Color fundus image:
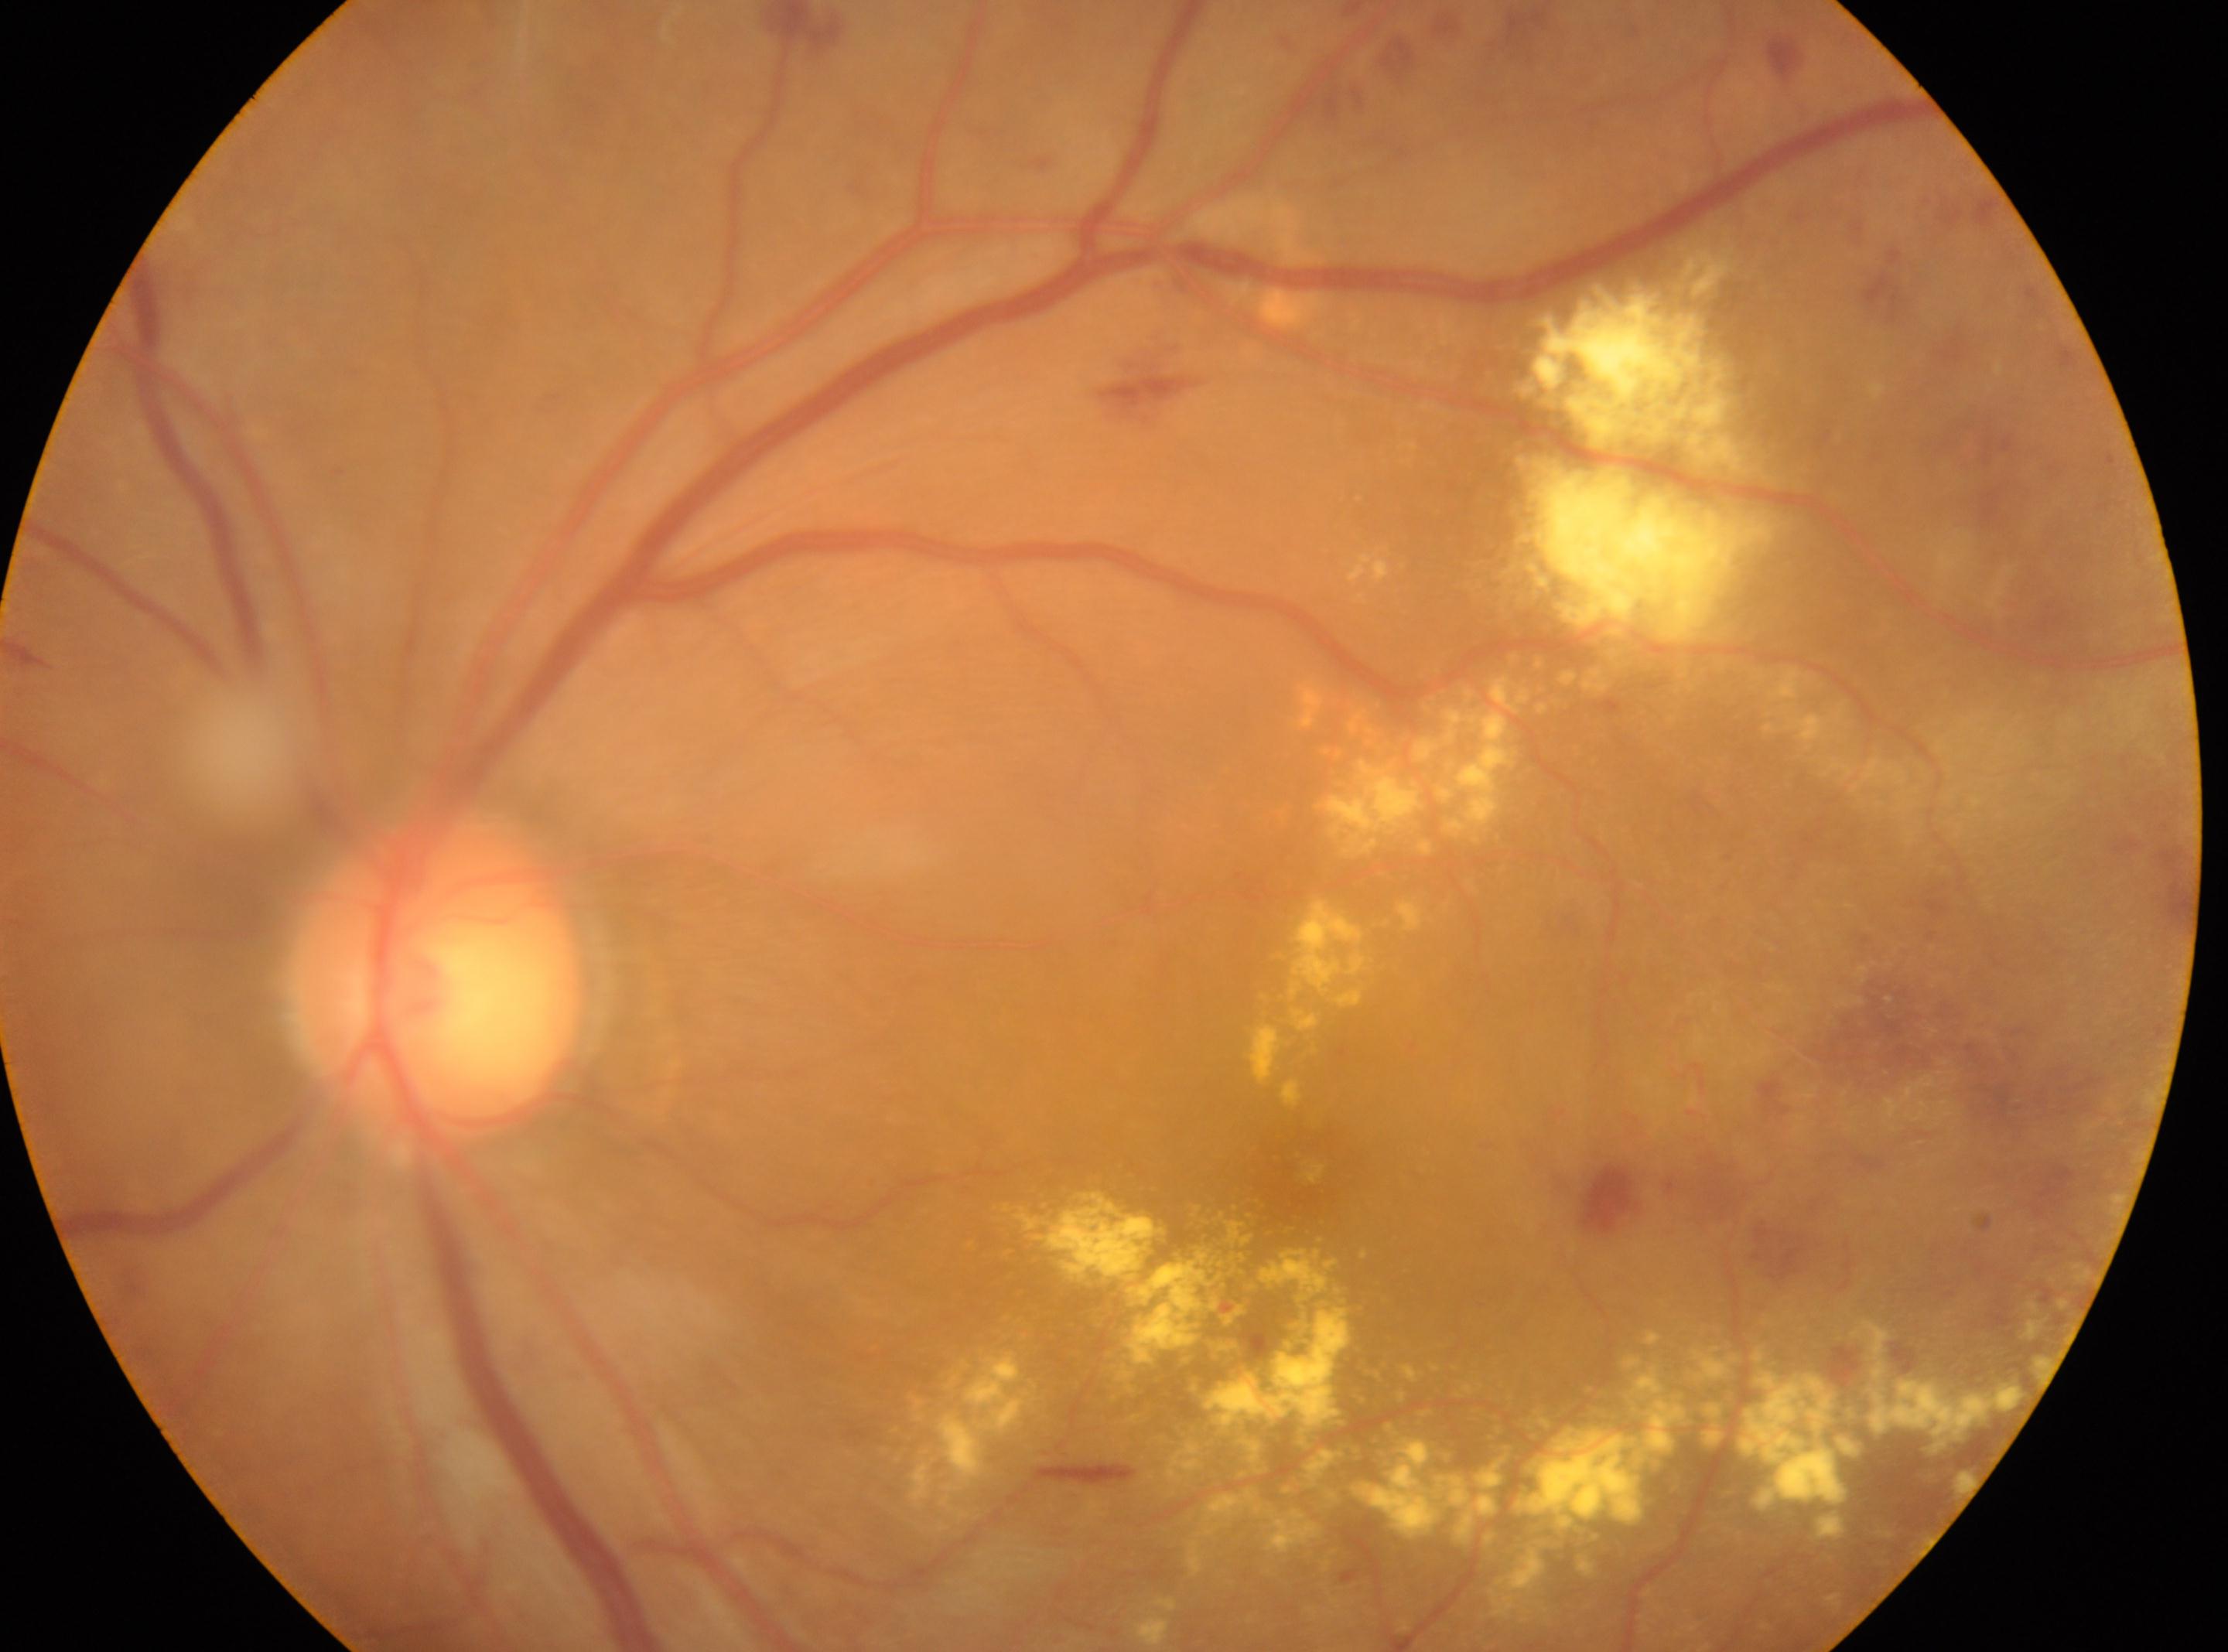

The image shows the left eye. DR grade is 2. Optic disc center: [436, 978]. The macular center is at [1301, 1172].